Wide-field contact fundus photograph of an infant · 100° field of view (Phoenix ICON) — 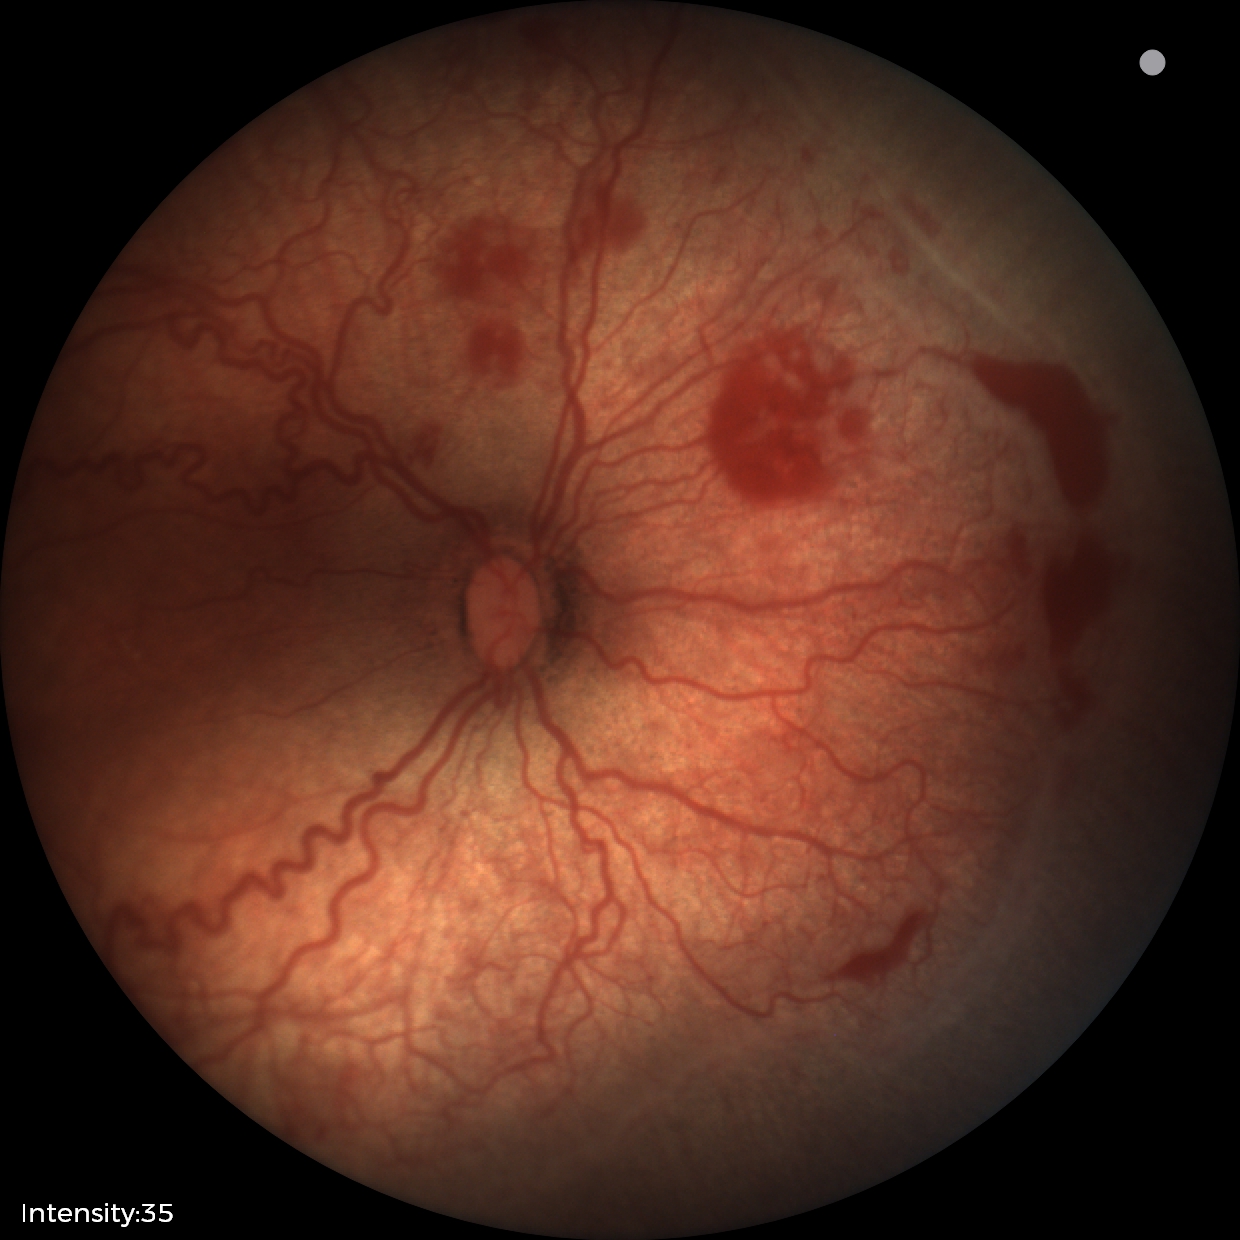
Screening diagnosis: ROP stage 2 — ridge with height and width at the demarcation line | plus disease.